45-degree field of view. 848 by 848 pixels
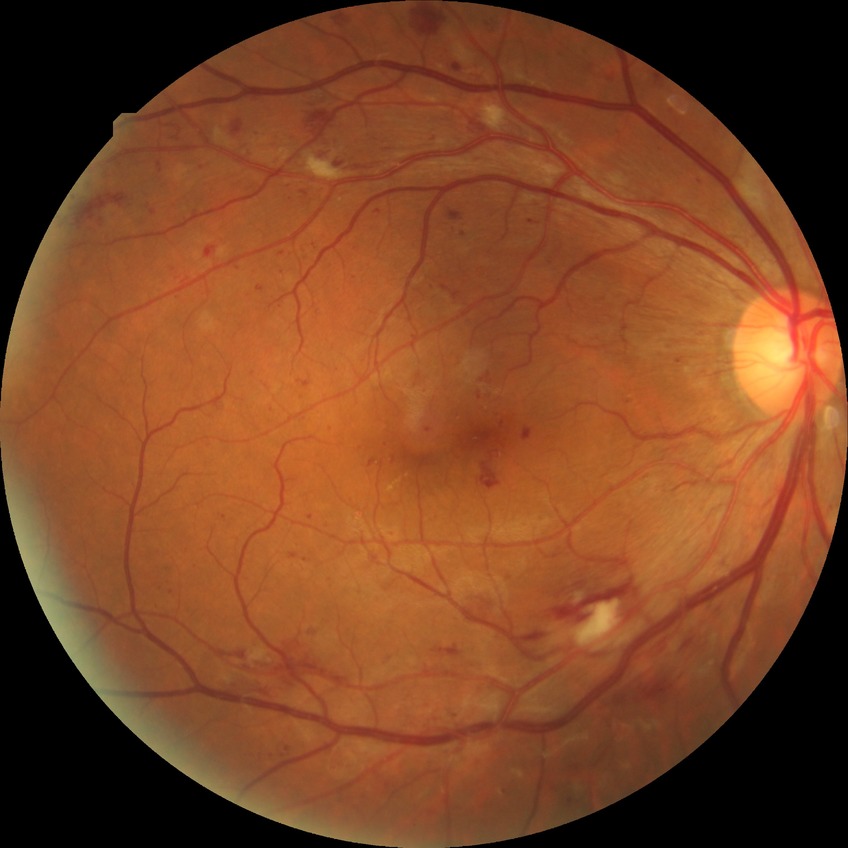

diabetic retinopathy (DR)@PPDR (pre-proliferative diabetic retinopathy).